Infant wide-field retinal image; image size 640x480; acquired on the Clarity RetCam 3:
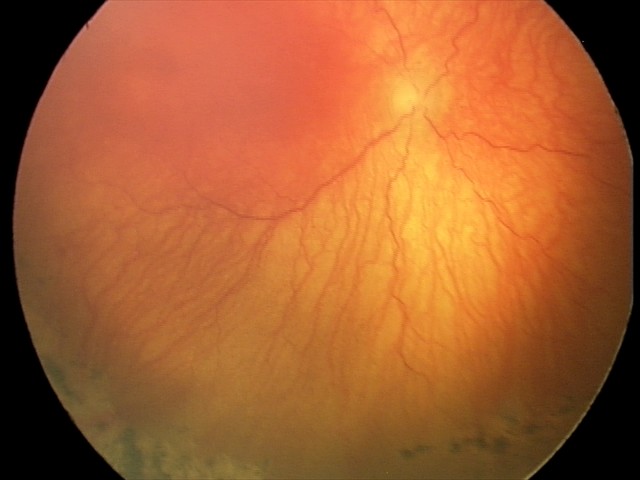

Impression = A-ROP (aggressive ROP), plus form = present.